CFP, 2089 by 1764 pixels:
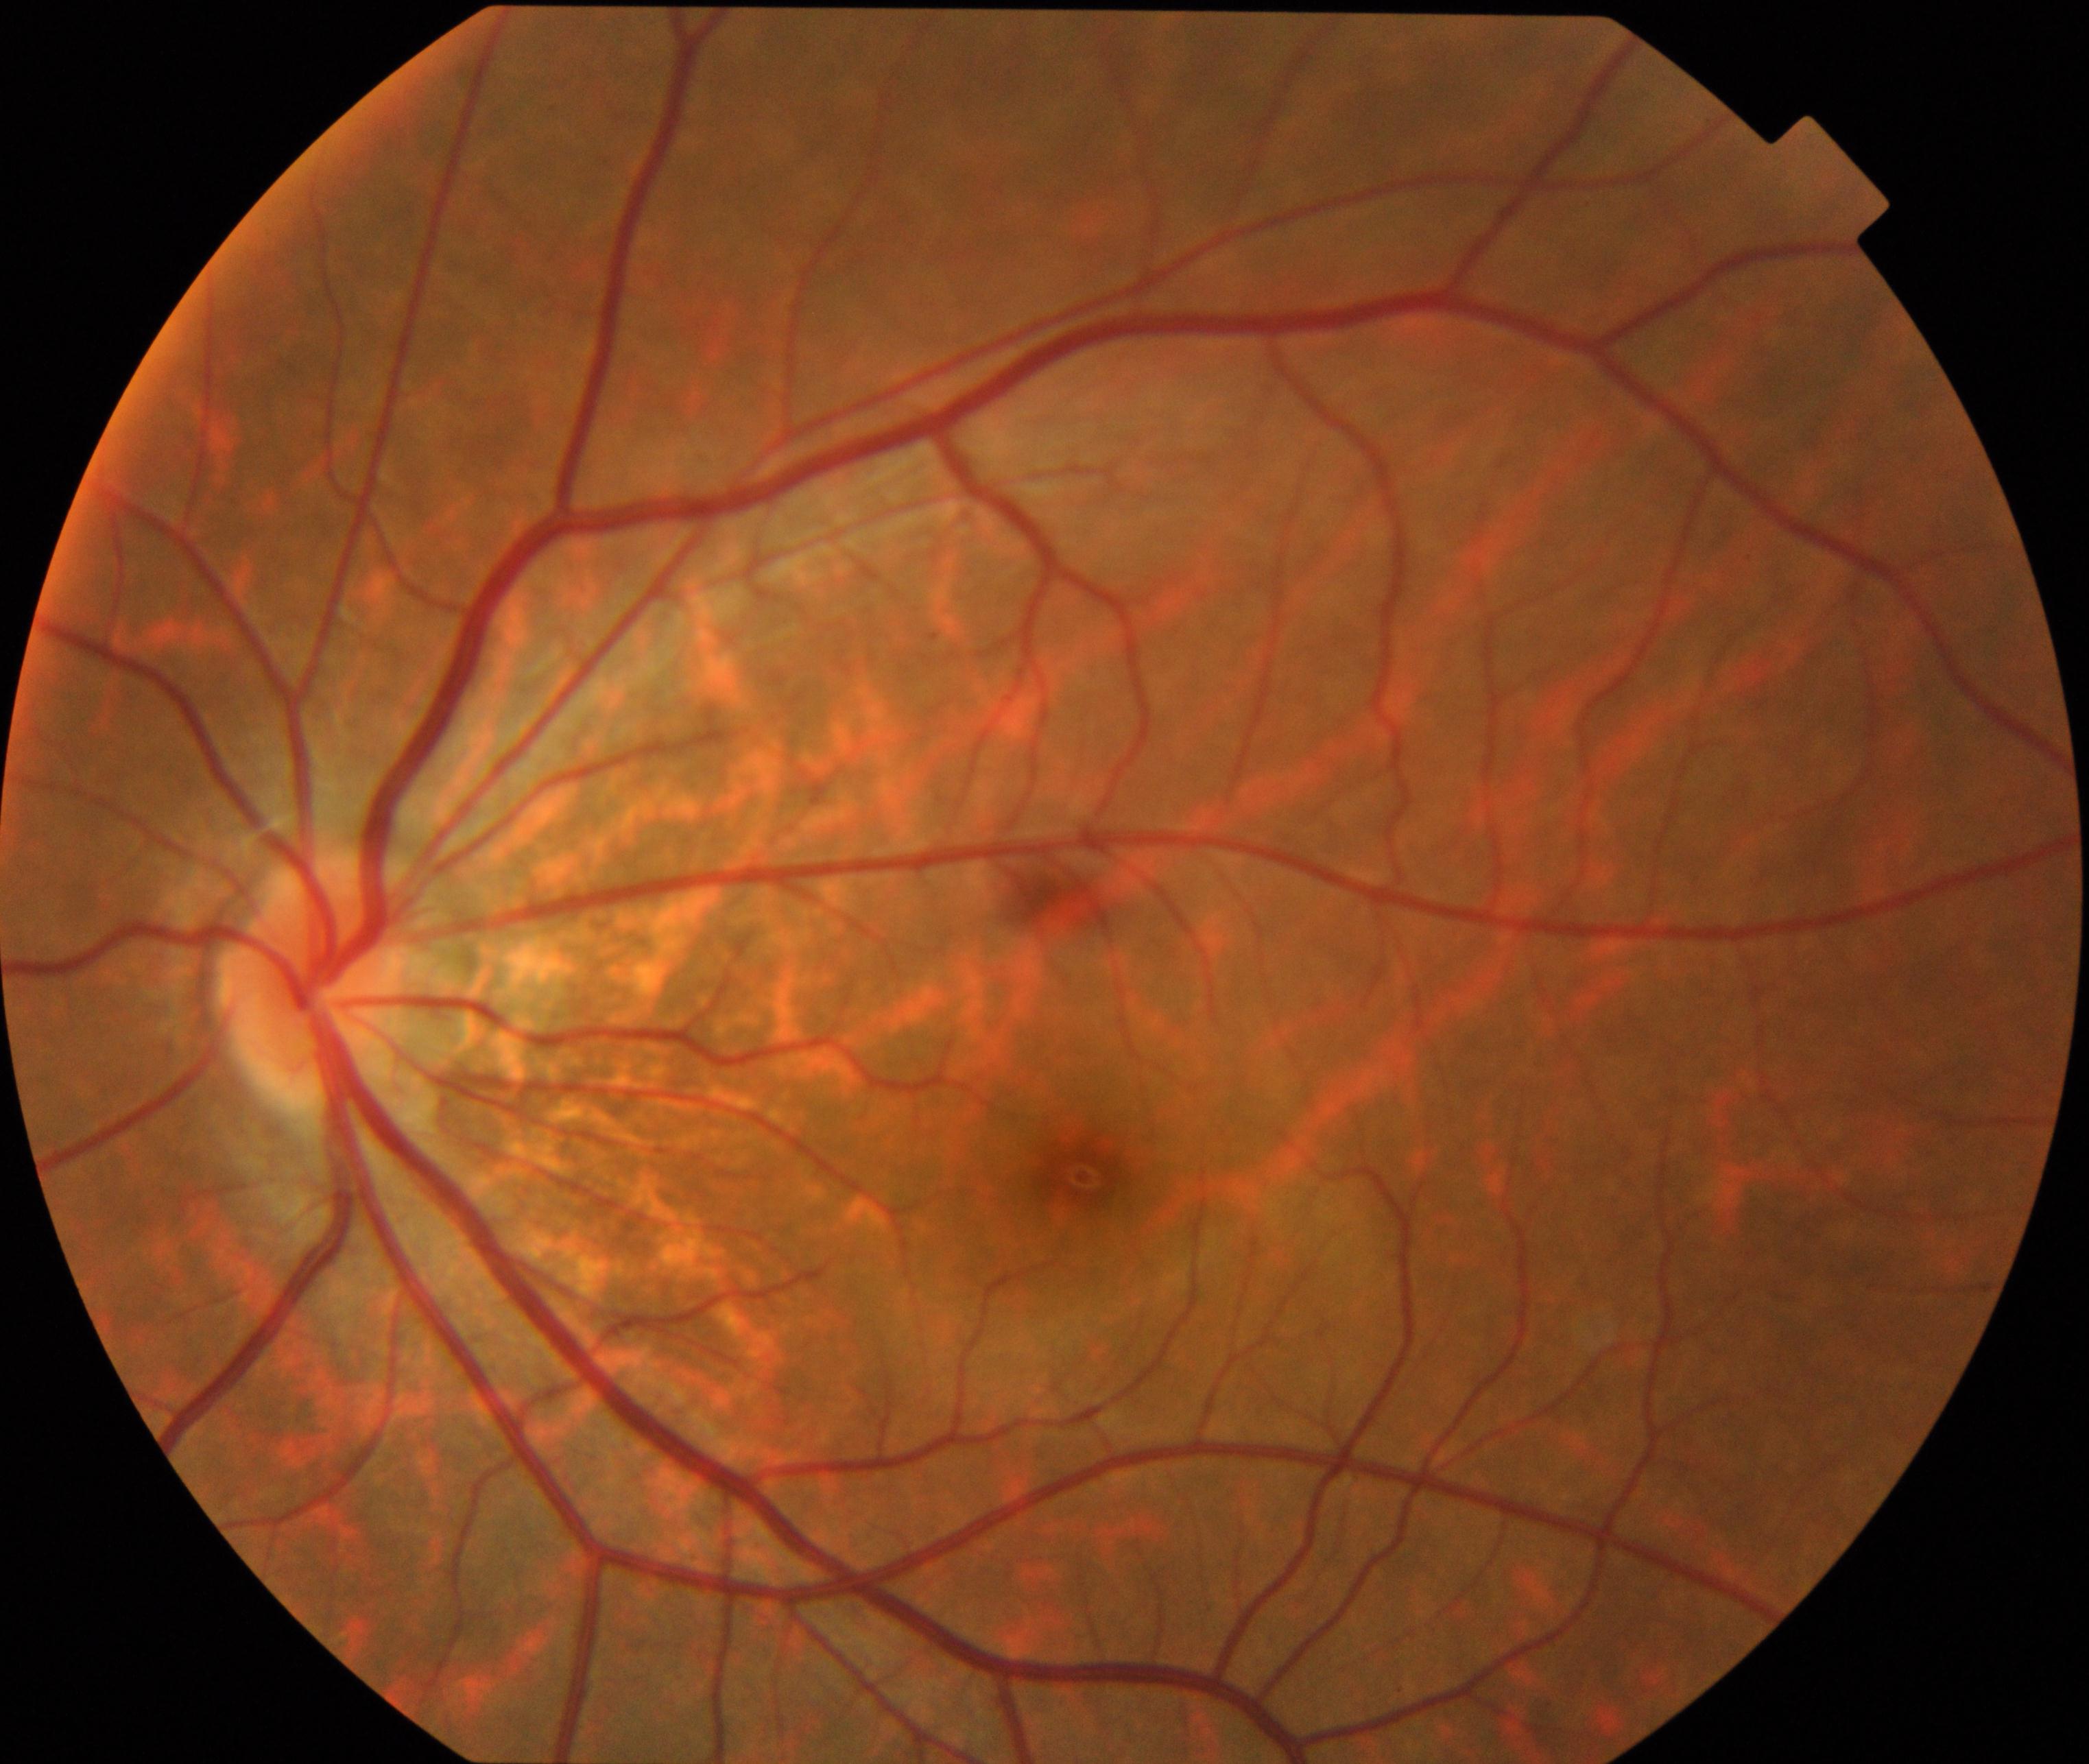
Primary finding: tessellated fundus.